200-degree field of view; UWF retinal mosaic
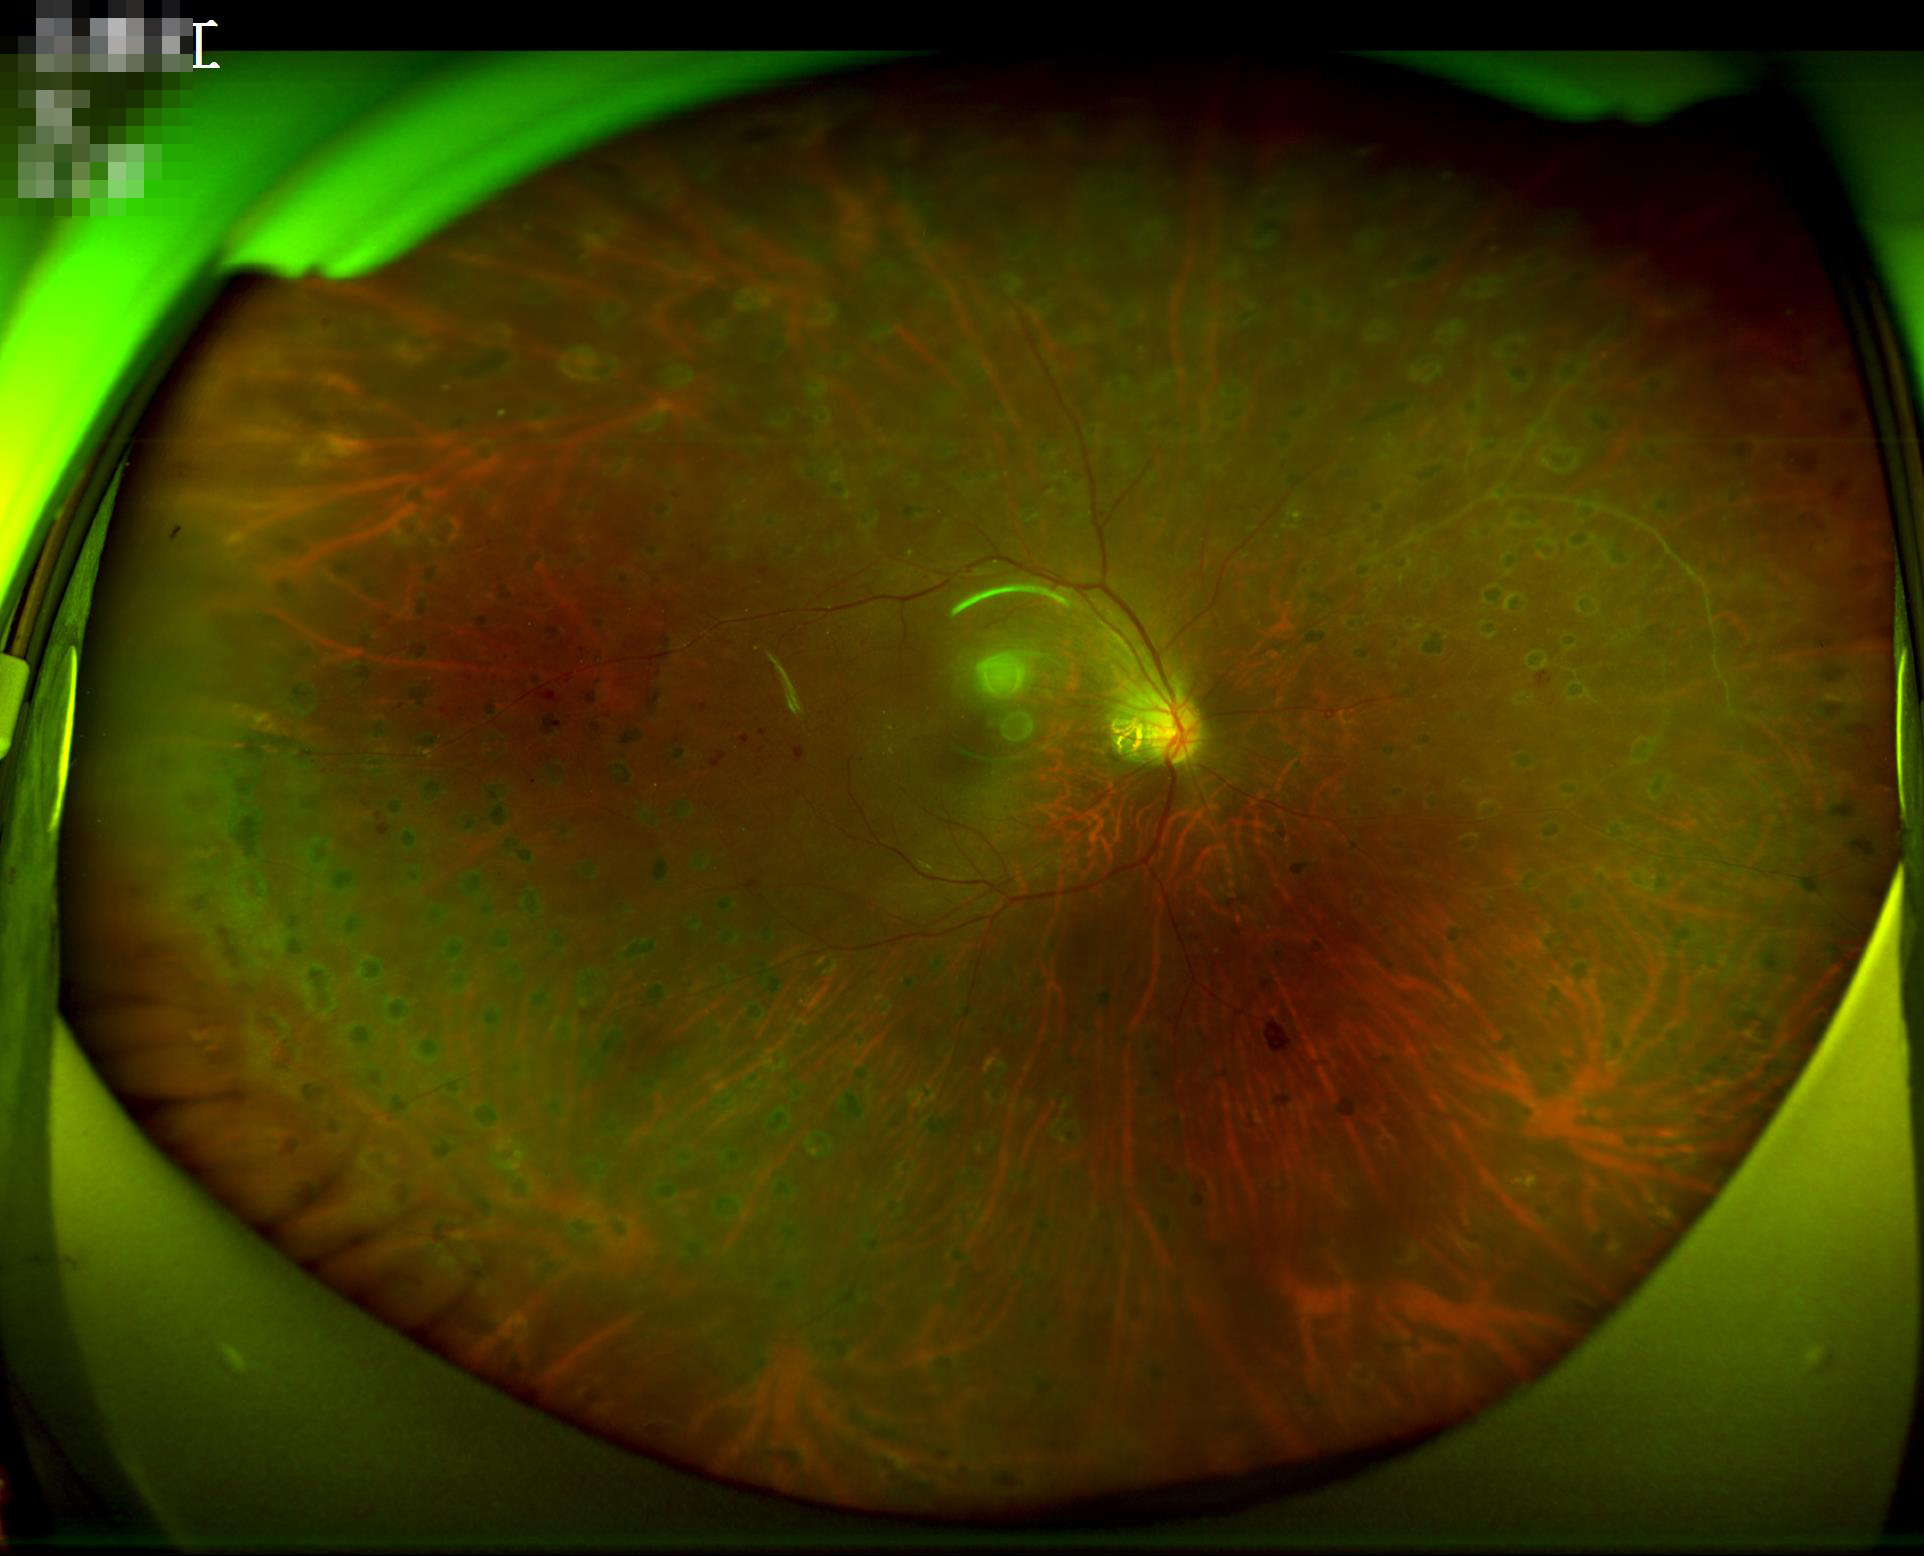
Quality assessment:
- illumination/color: good illumination and color balance
- sharpness: optic disc, vessels, and background in focus
- overall: good and suitable for diagnostic use
- contrast: wide intensity range, structures distinguishable